45 degree fundus photograph. 848x848. Nonmydriatic fundus photograph. Posterior pole color fundus photograph — 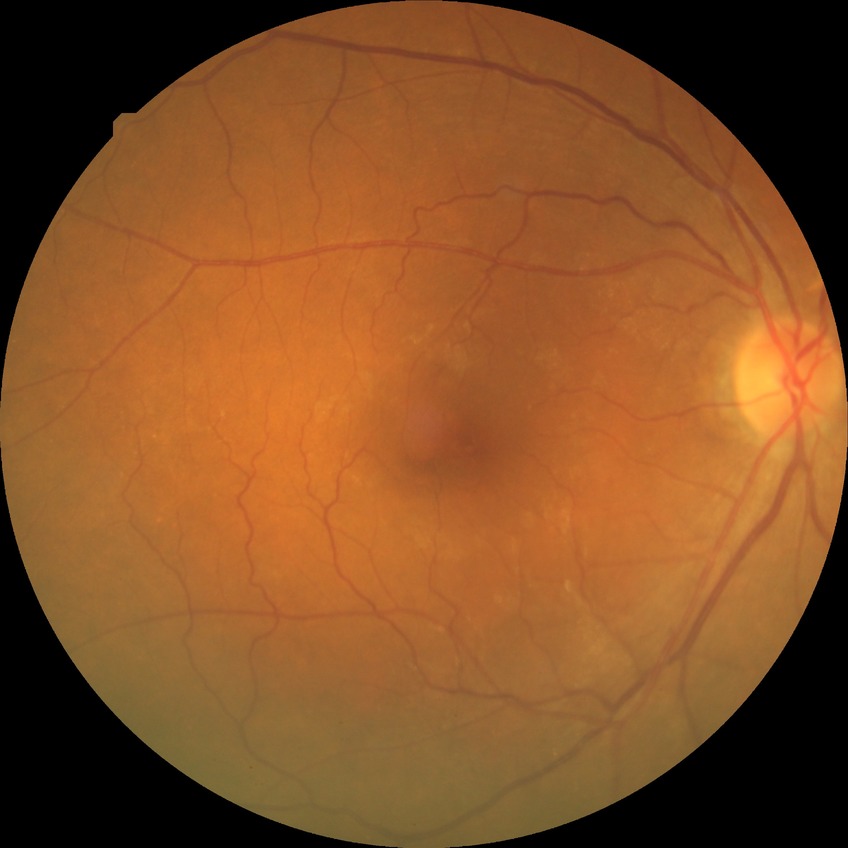

Diabetic retinopathy (DR): NDR (no diabetic retinopathy).